1440x1080px · RetCam wide-field infant fundus image: 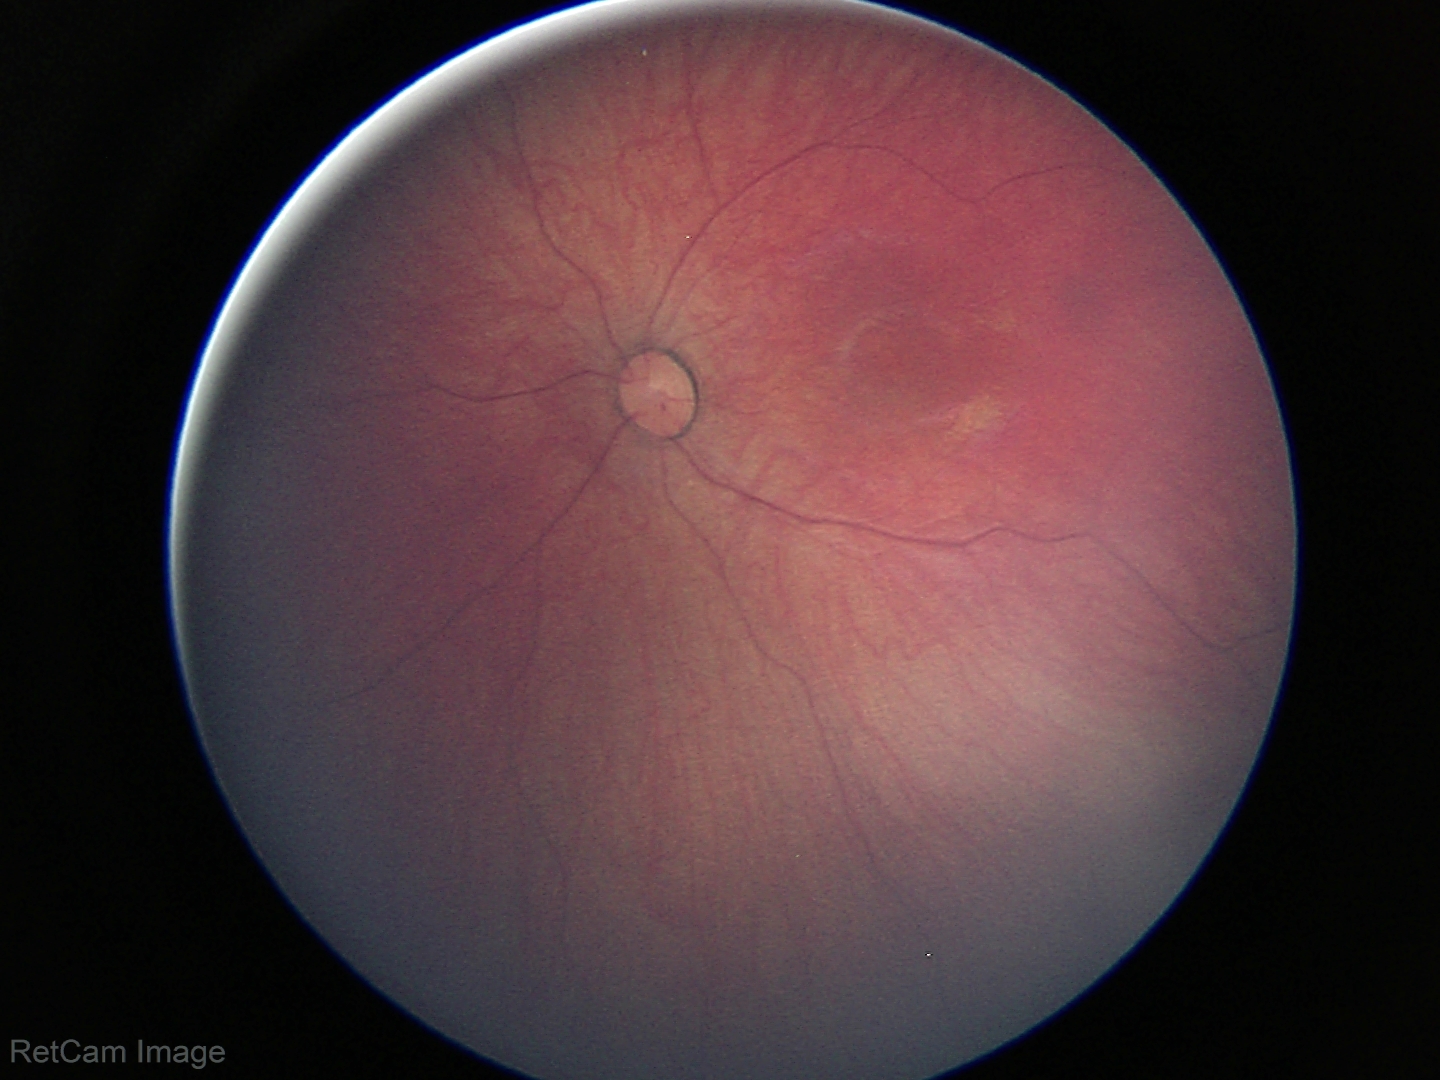
Screening examination with no abnormal retinal findings.